Wide-field contact fundus photograph of an infant.
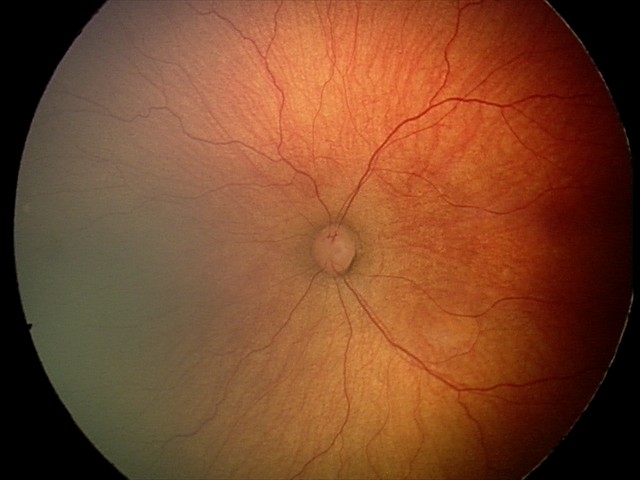
Diagnosis from this screening exam: retinopathy of prematurity stage 2 — ridge with height and width at the demarcation line. No plus disease.